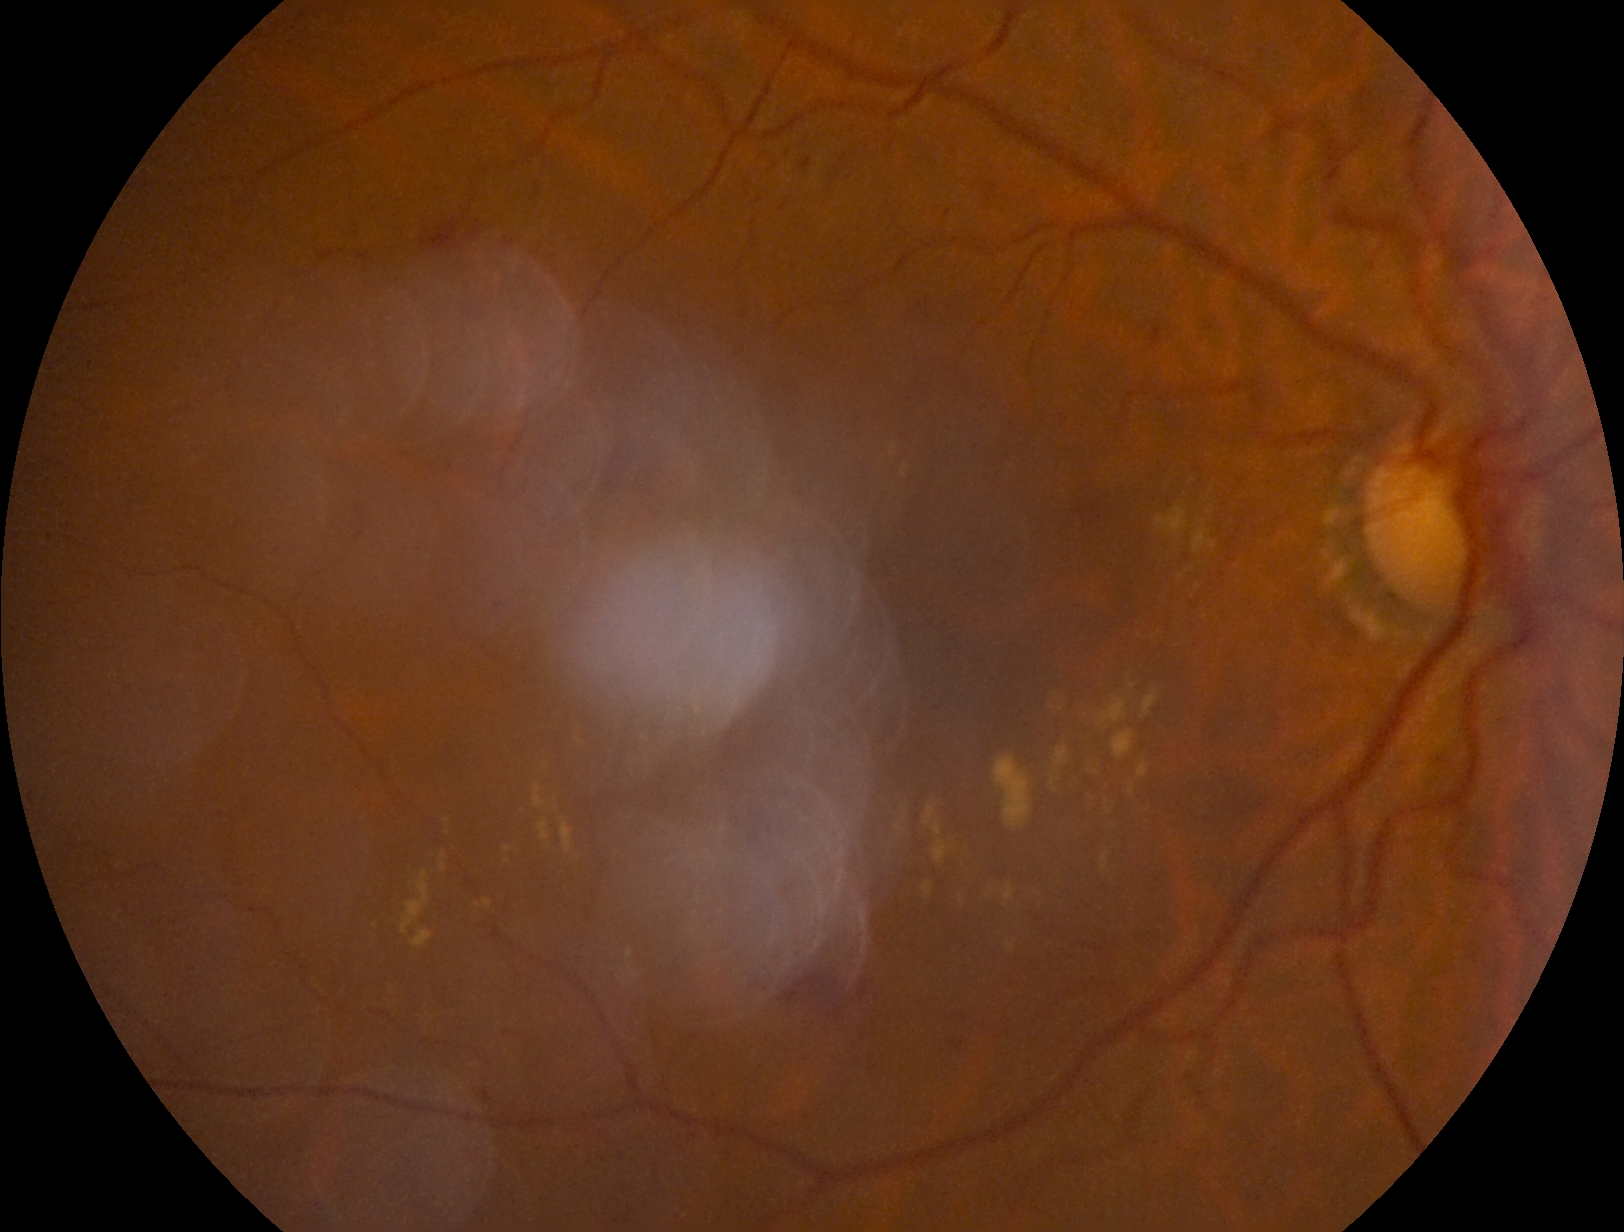   dr_grade: moderate NPDR (grade 2)
  dr_category: non-proliferative diabetic retinopathy